Color fundus image; 45-degree field of view:
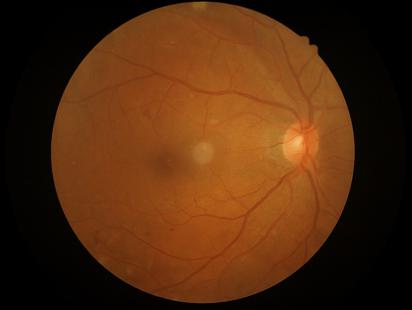 Quality grading: contrast: satisfactory; clarity: good.